2089x1764px; CFP — 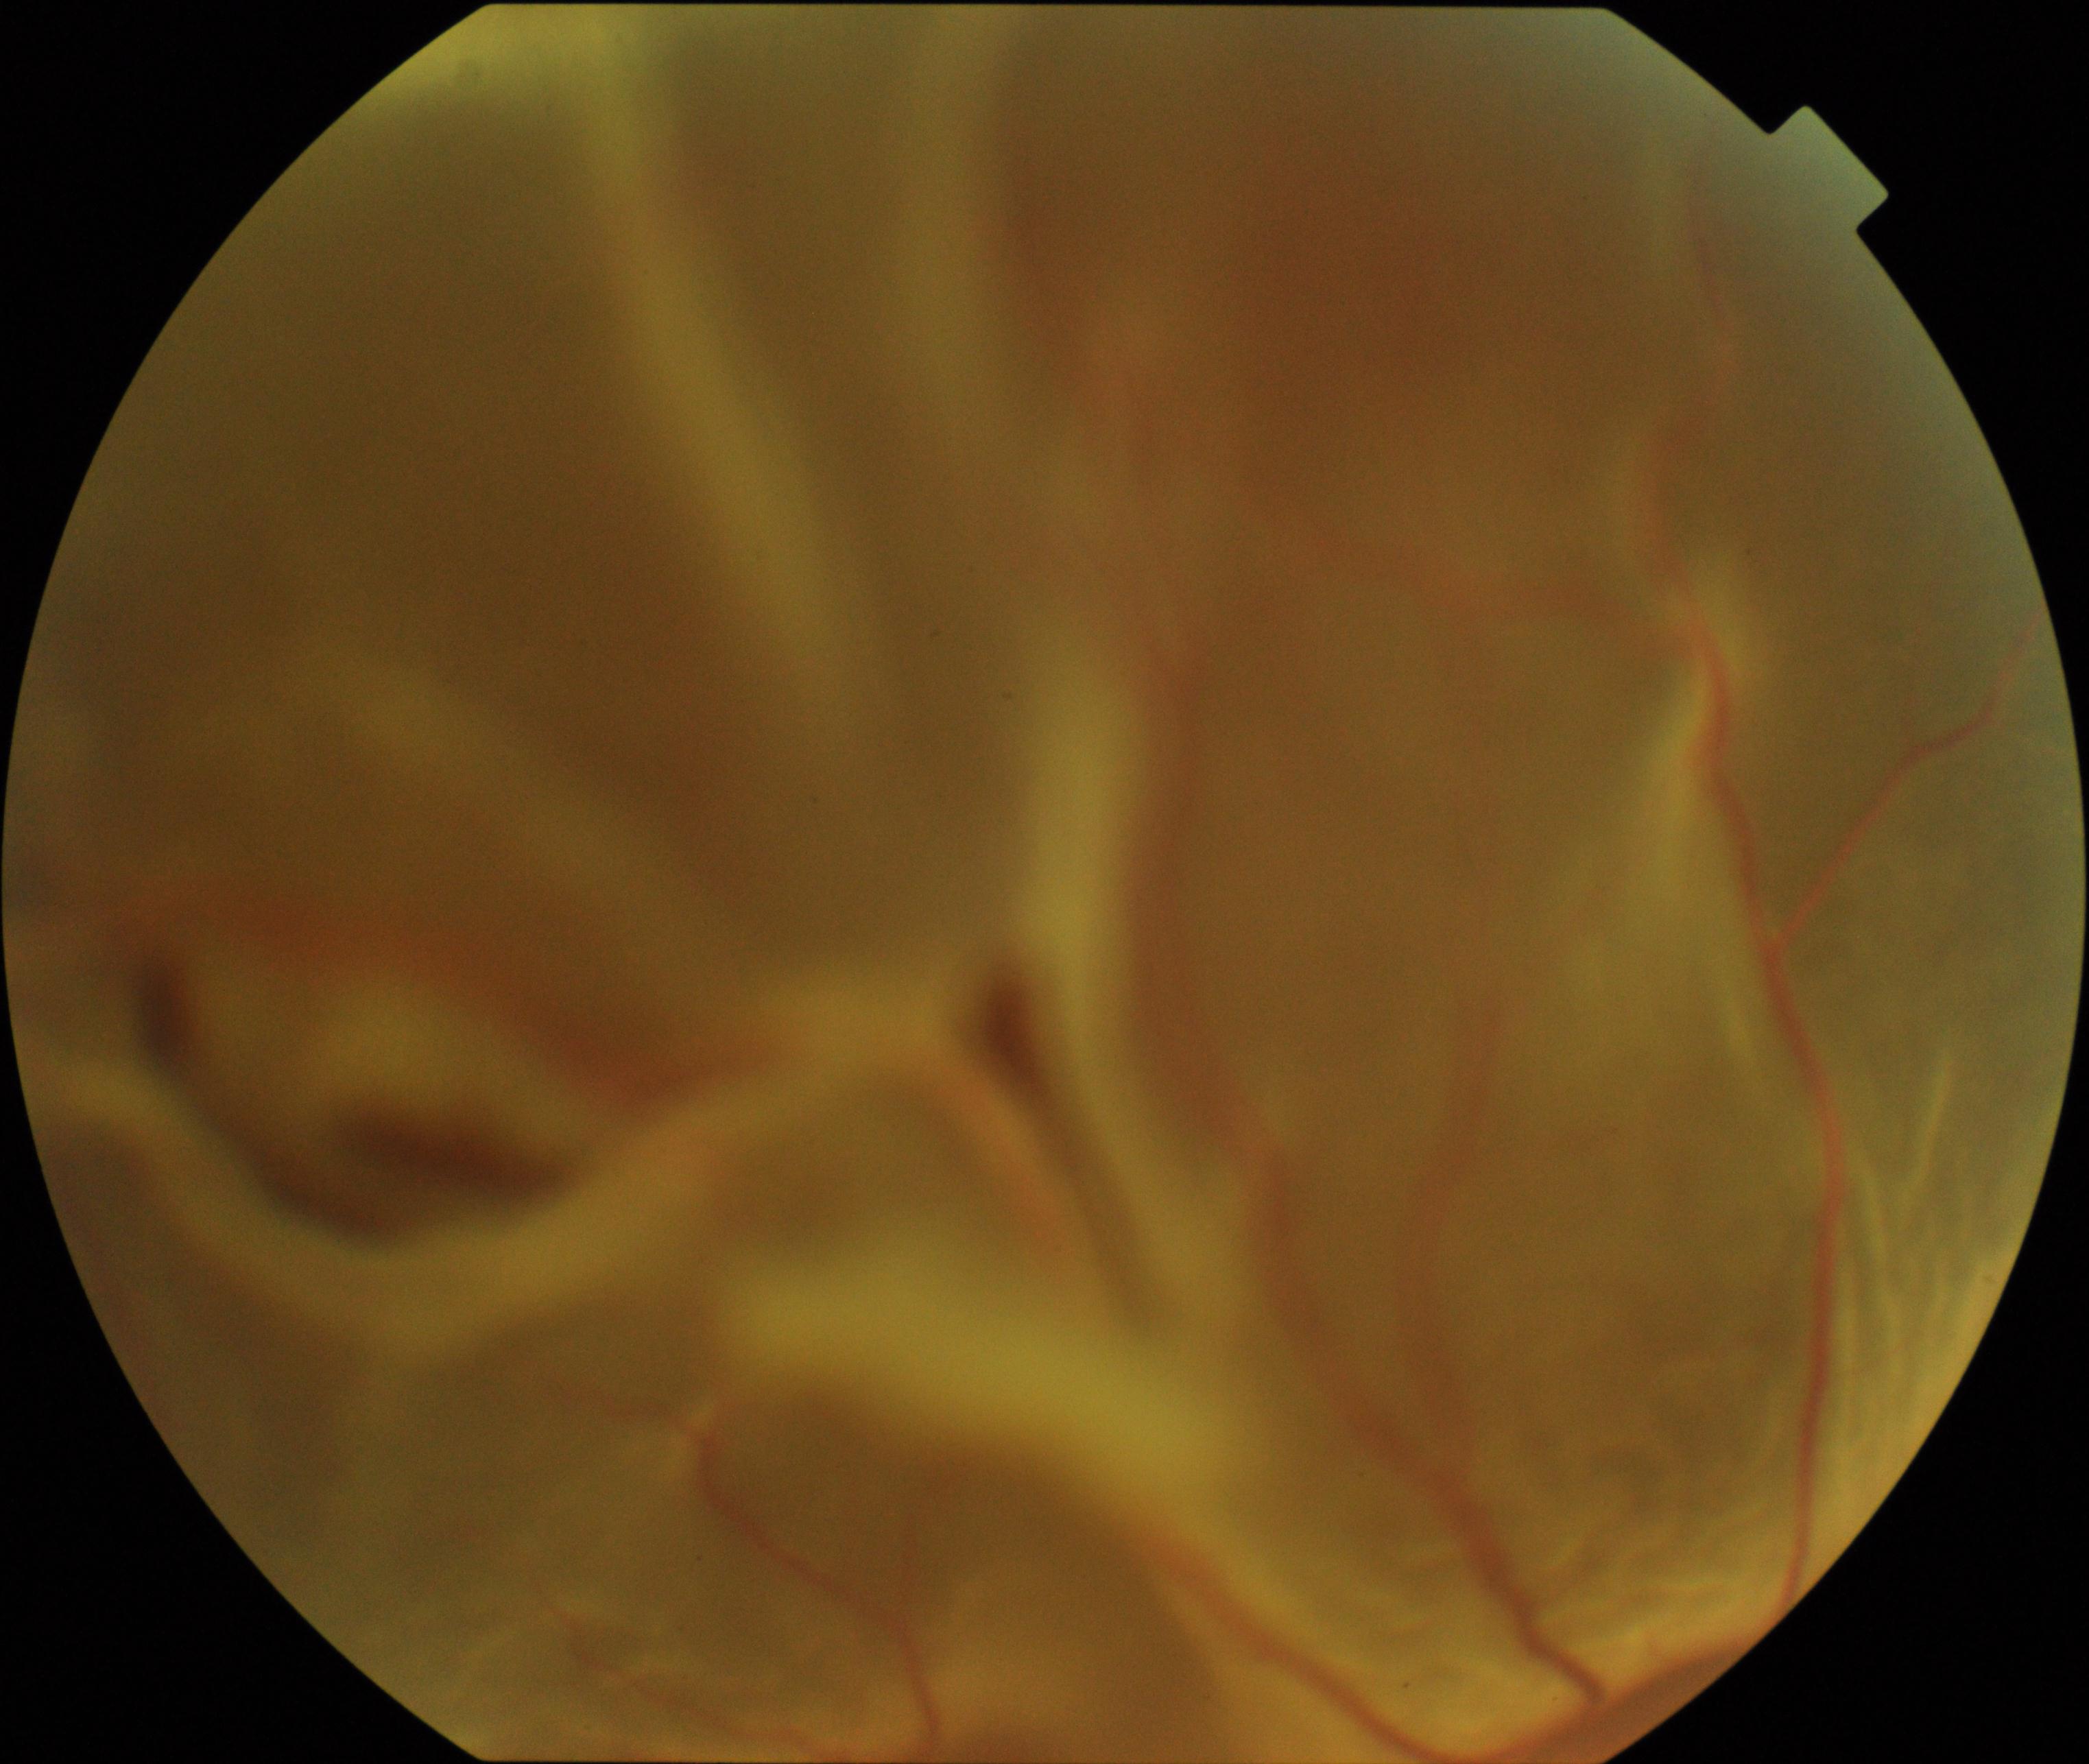
There is evidence of rhegmatogenous retinal detachment.